CFP. 45° field of view. 2048x1536px:
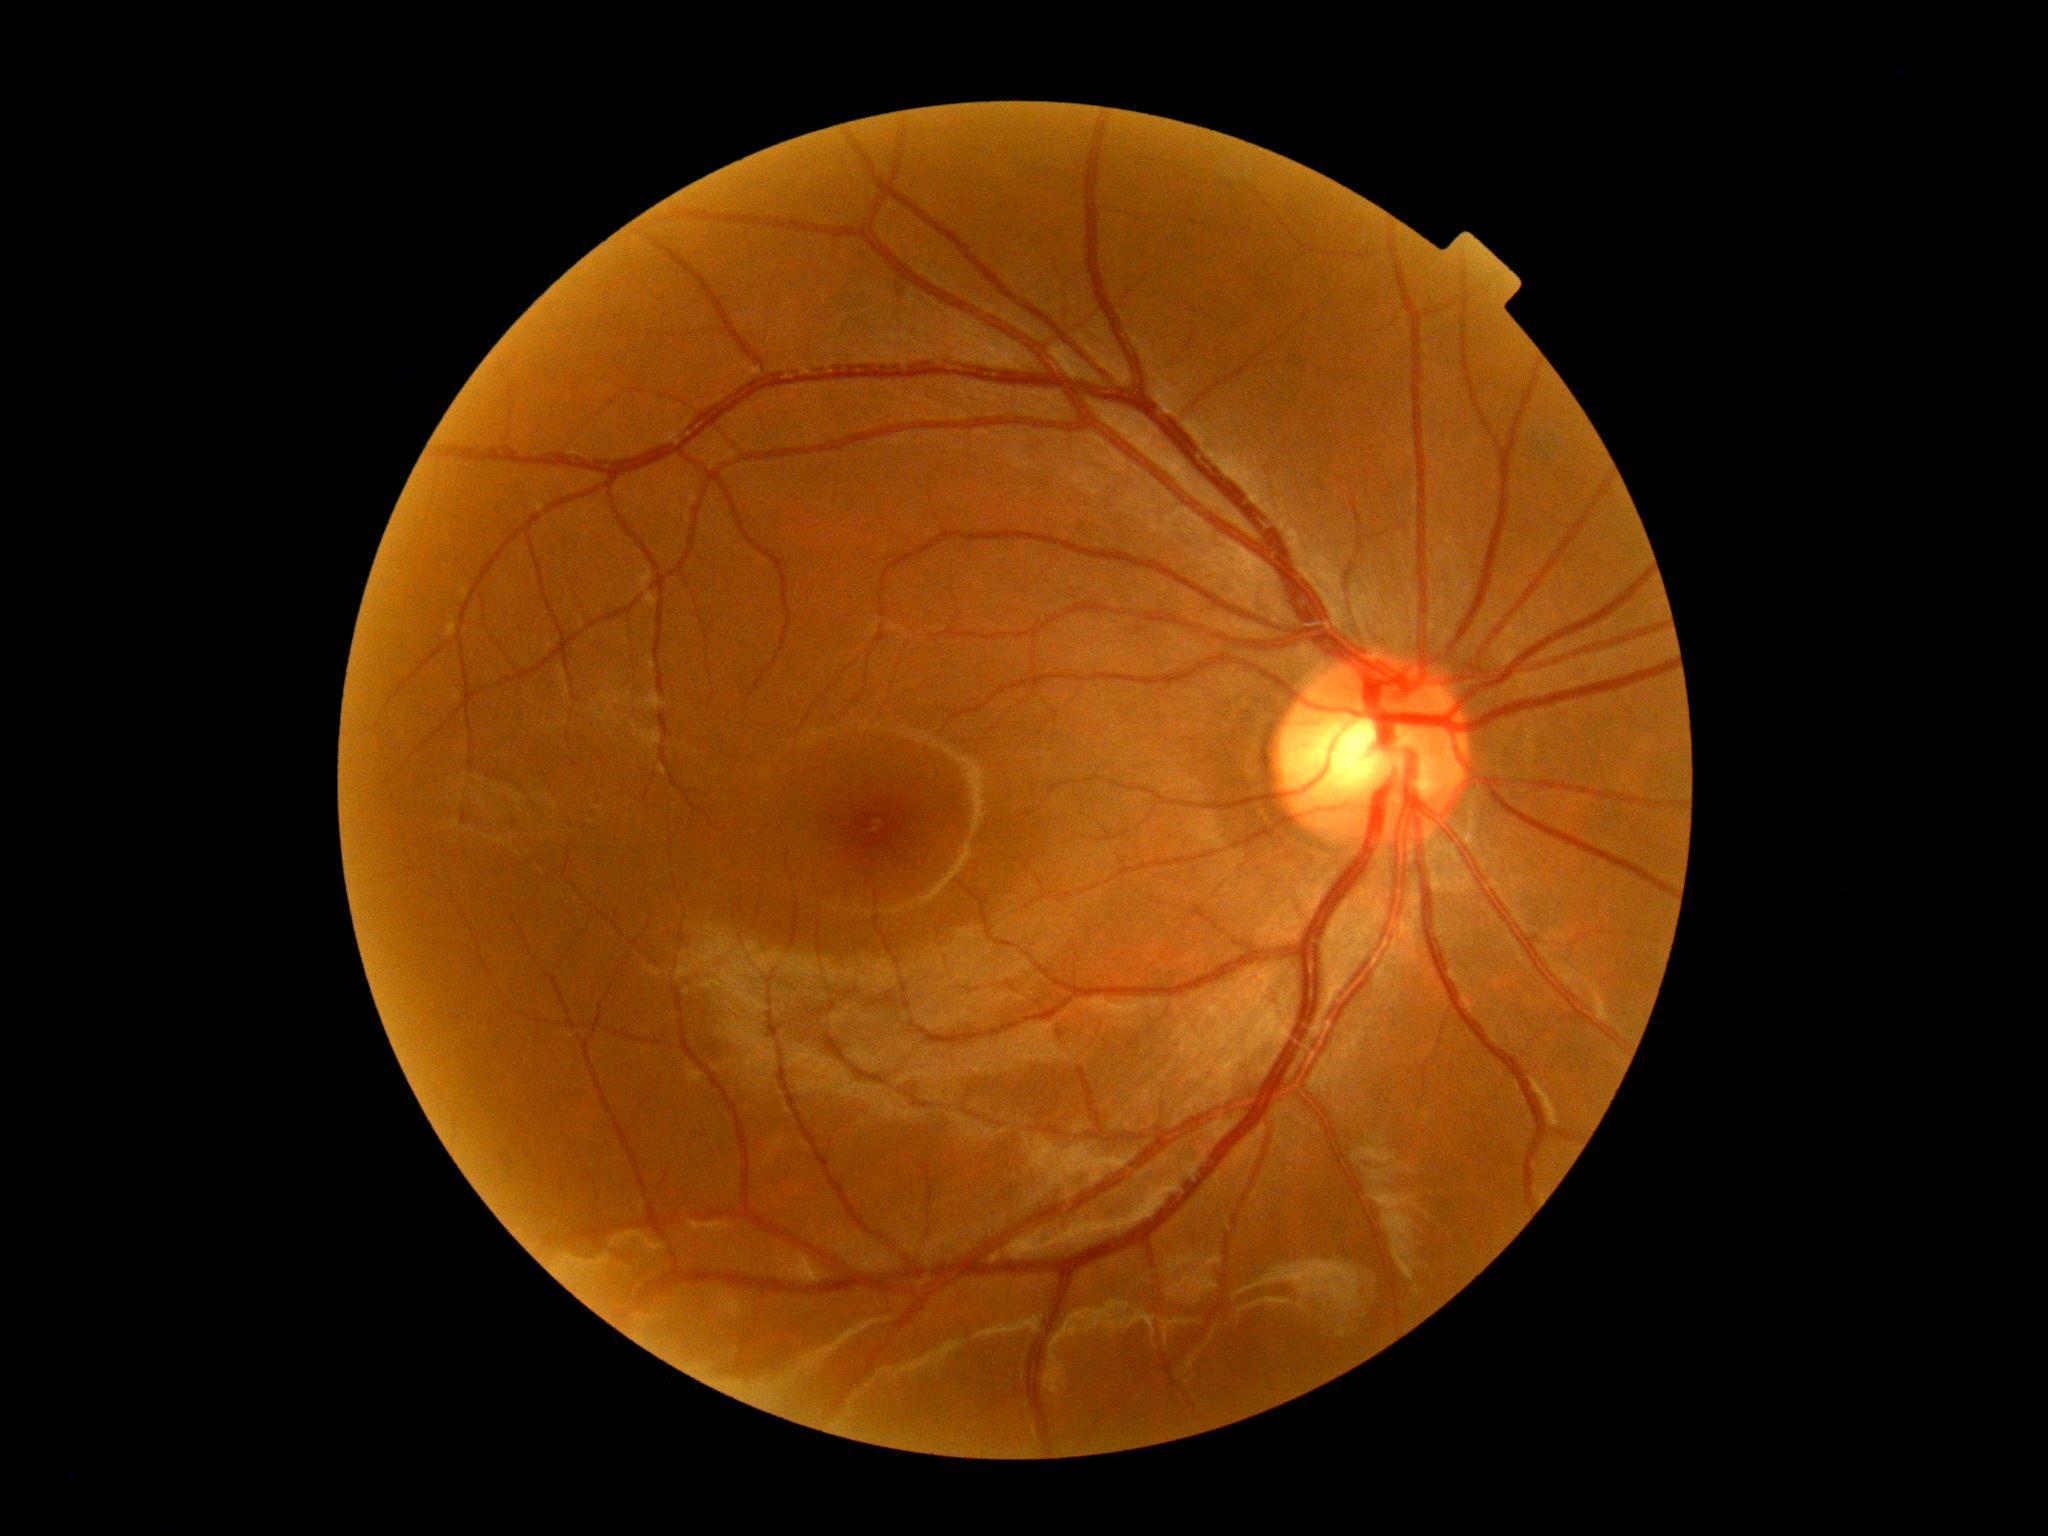

DR grade: 0.